CFP
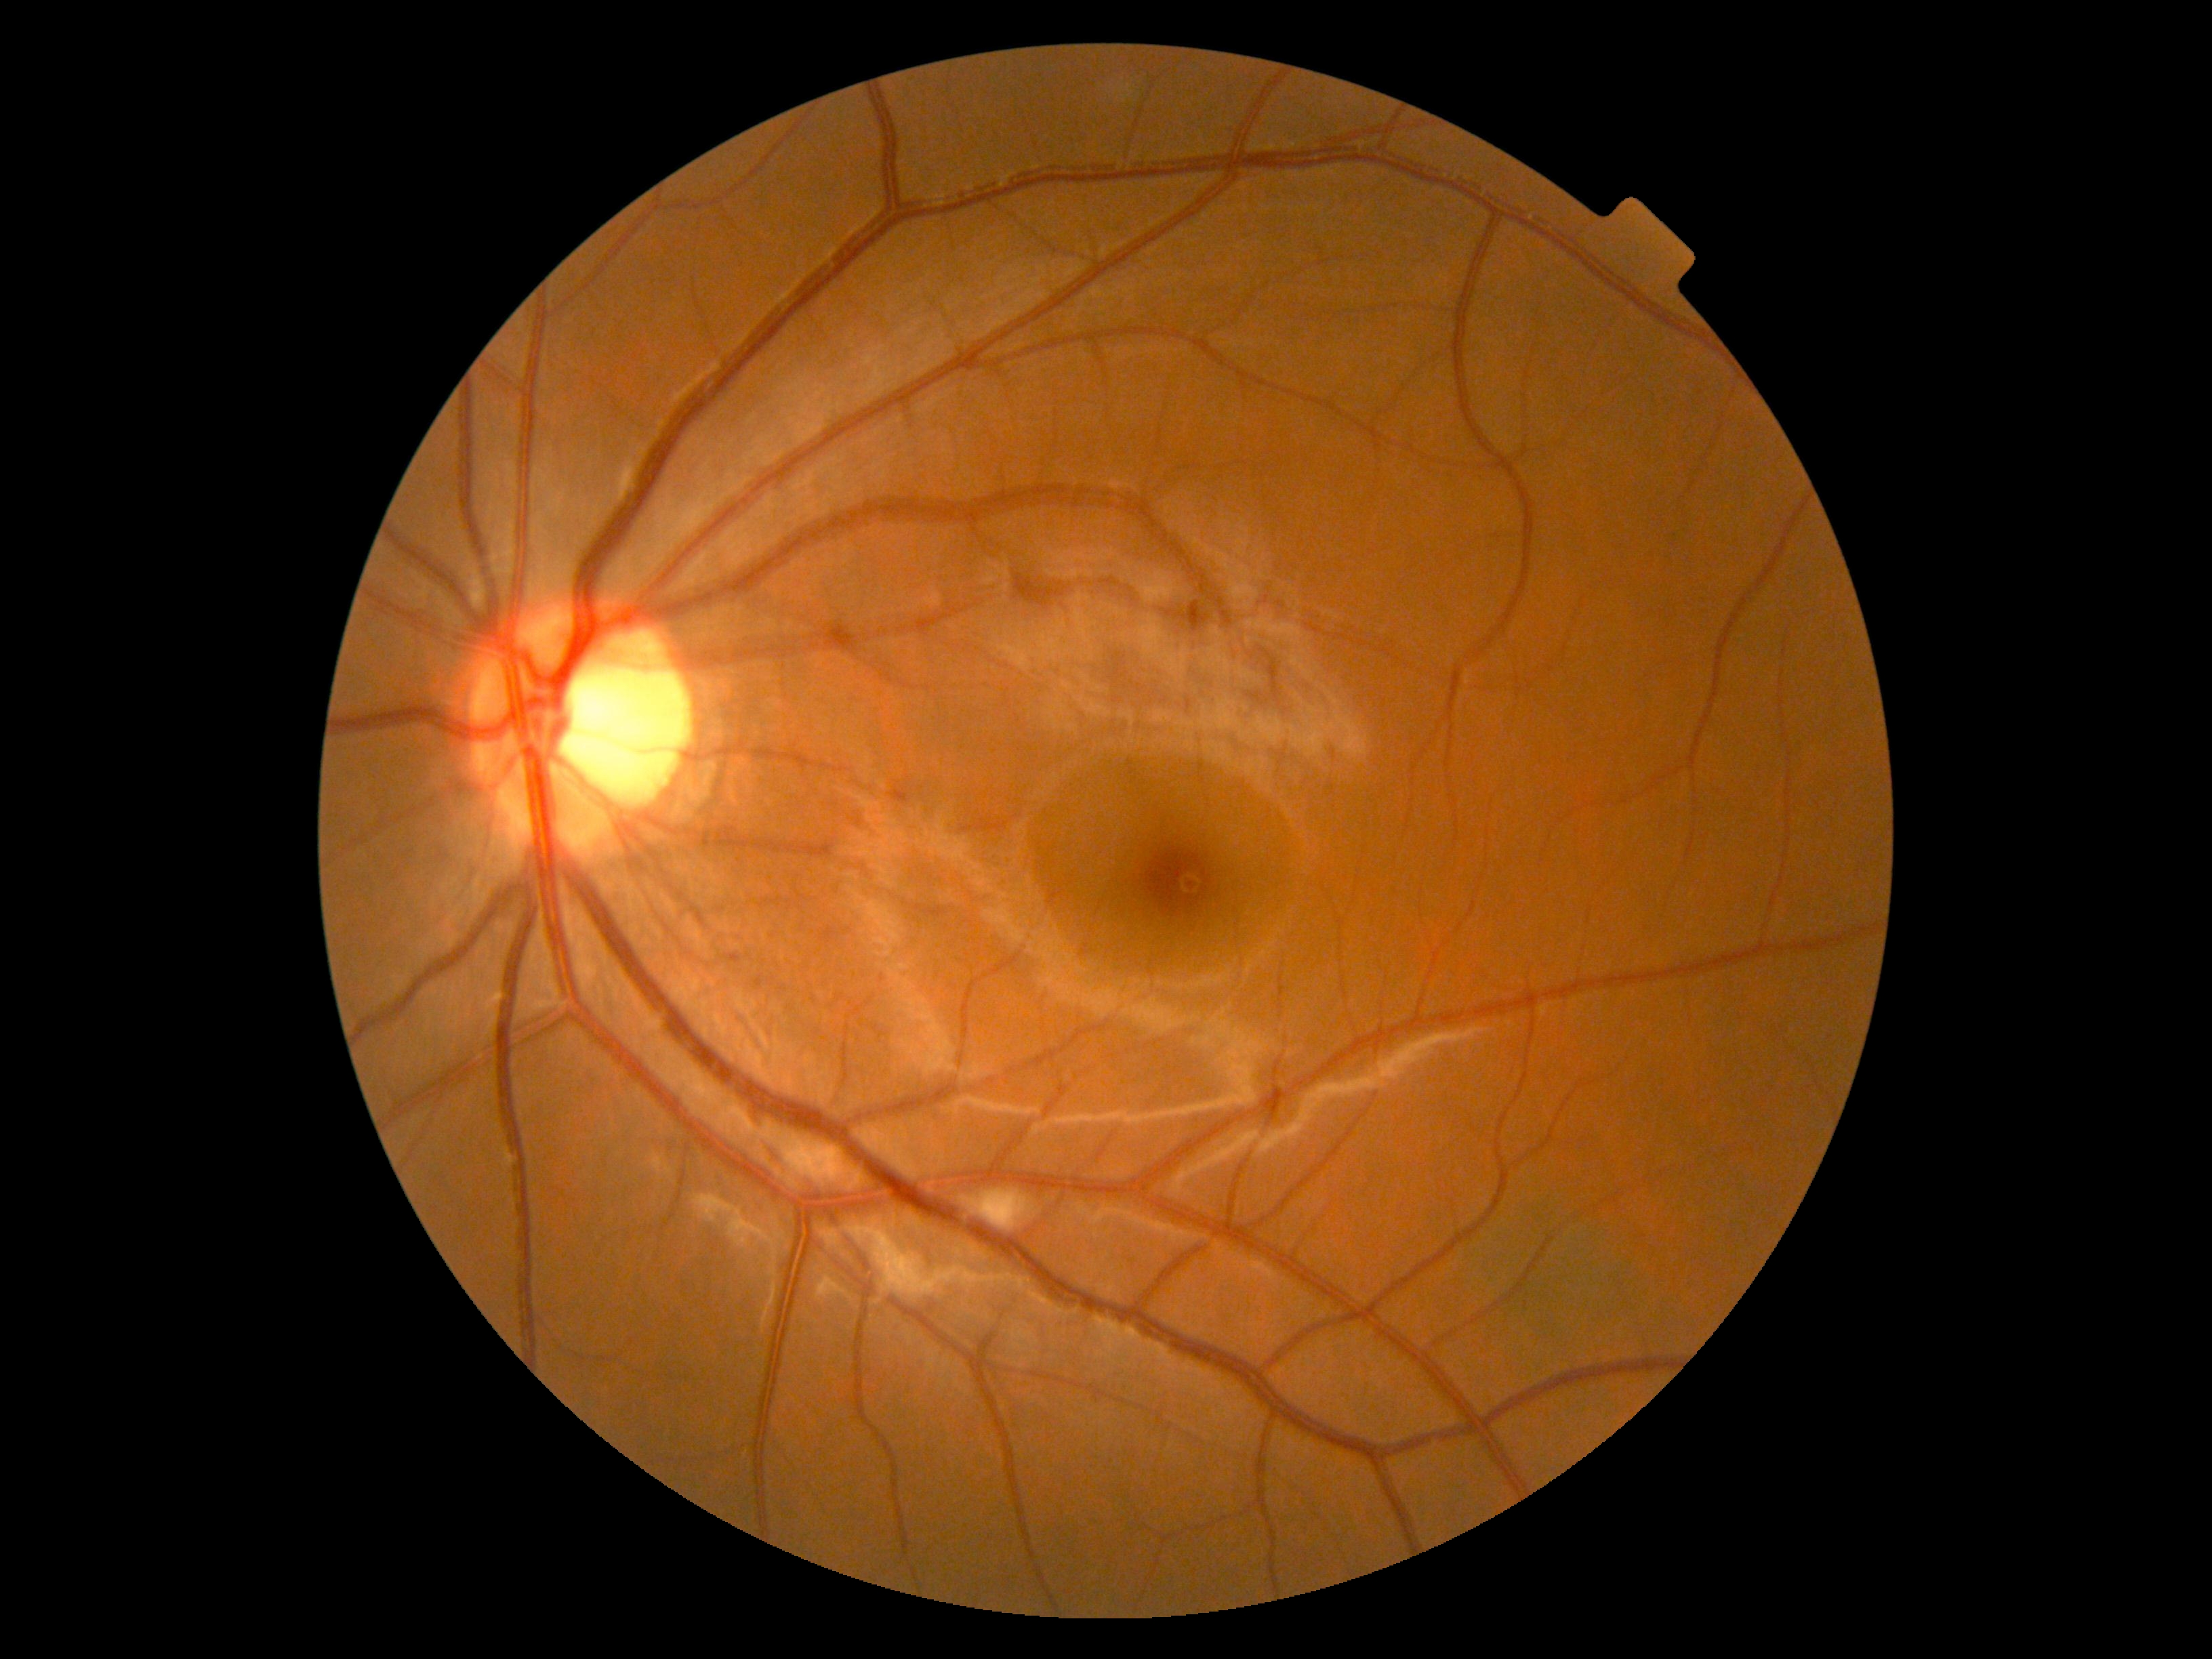

No apparent diabetic retinopathy.
DR grade is 0.